45° field of view, color fundus image, without pupil dilation, DR severity per modified Davis staging, 848 by 848 pixels, NIDEK AFC-230.
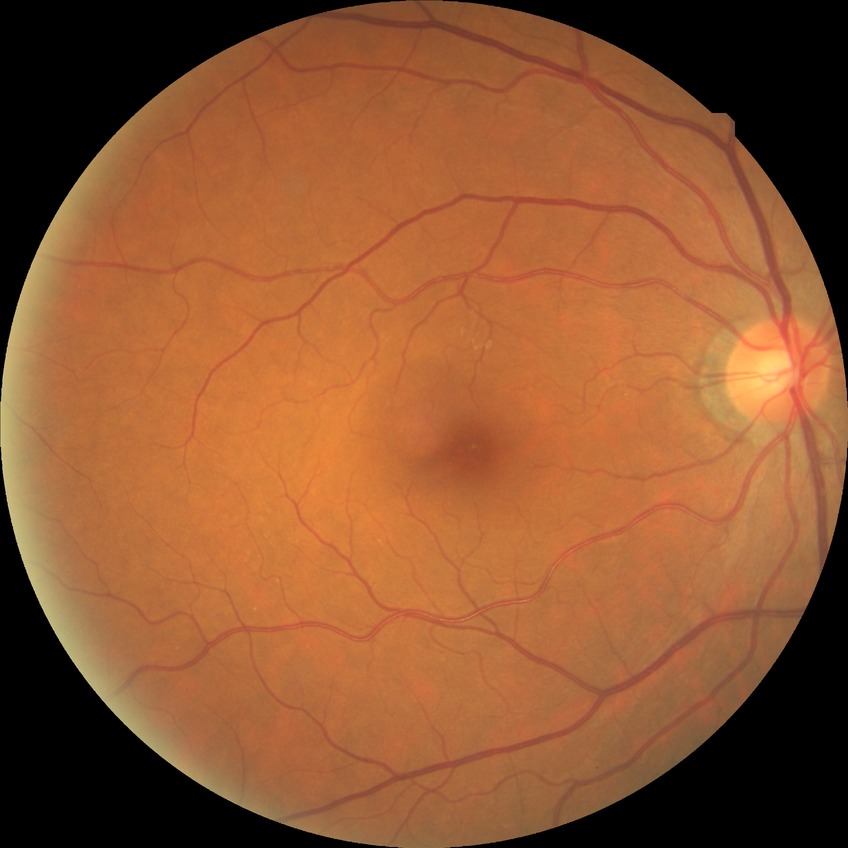 Davis DR grade: NDR.